CFP · 2352 x 1568 pixels:
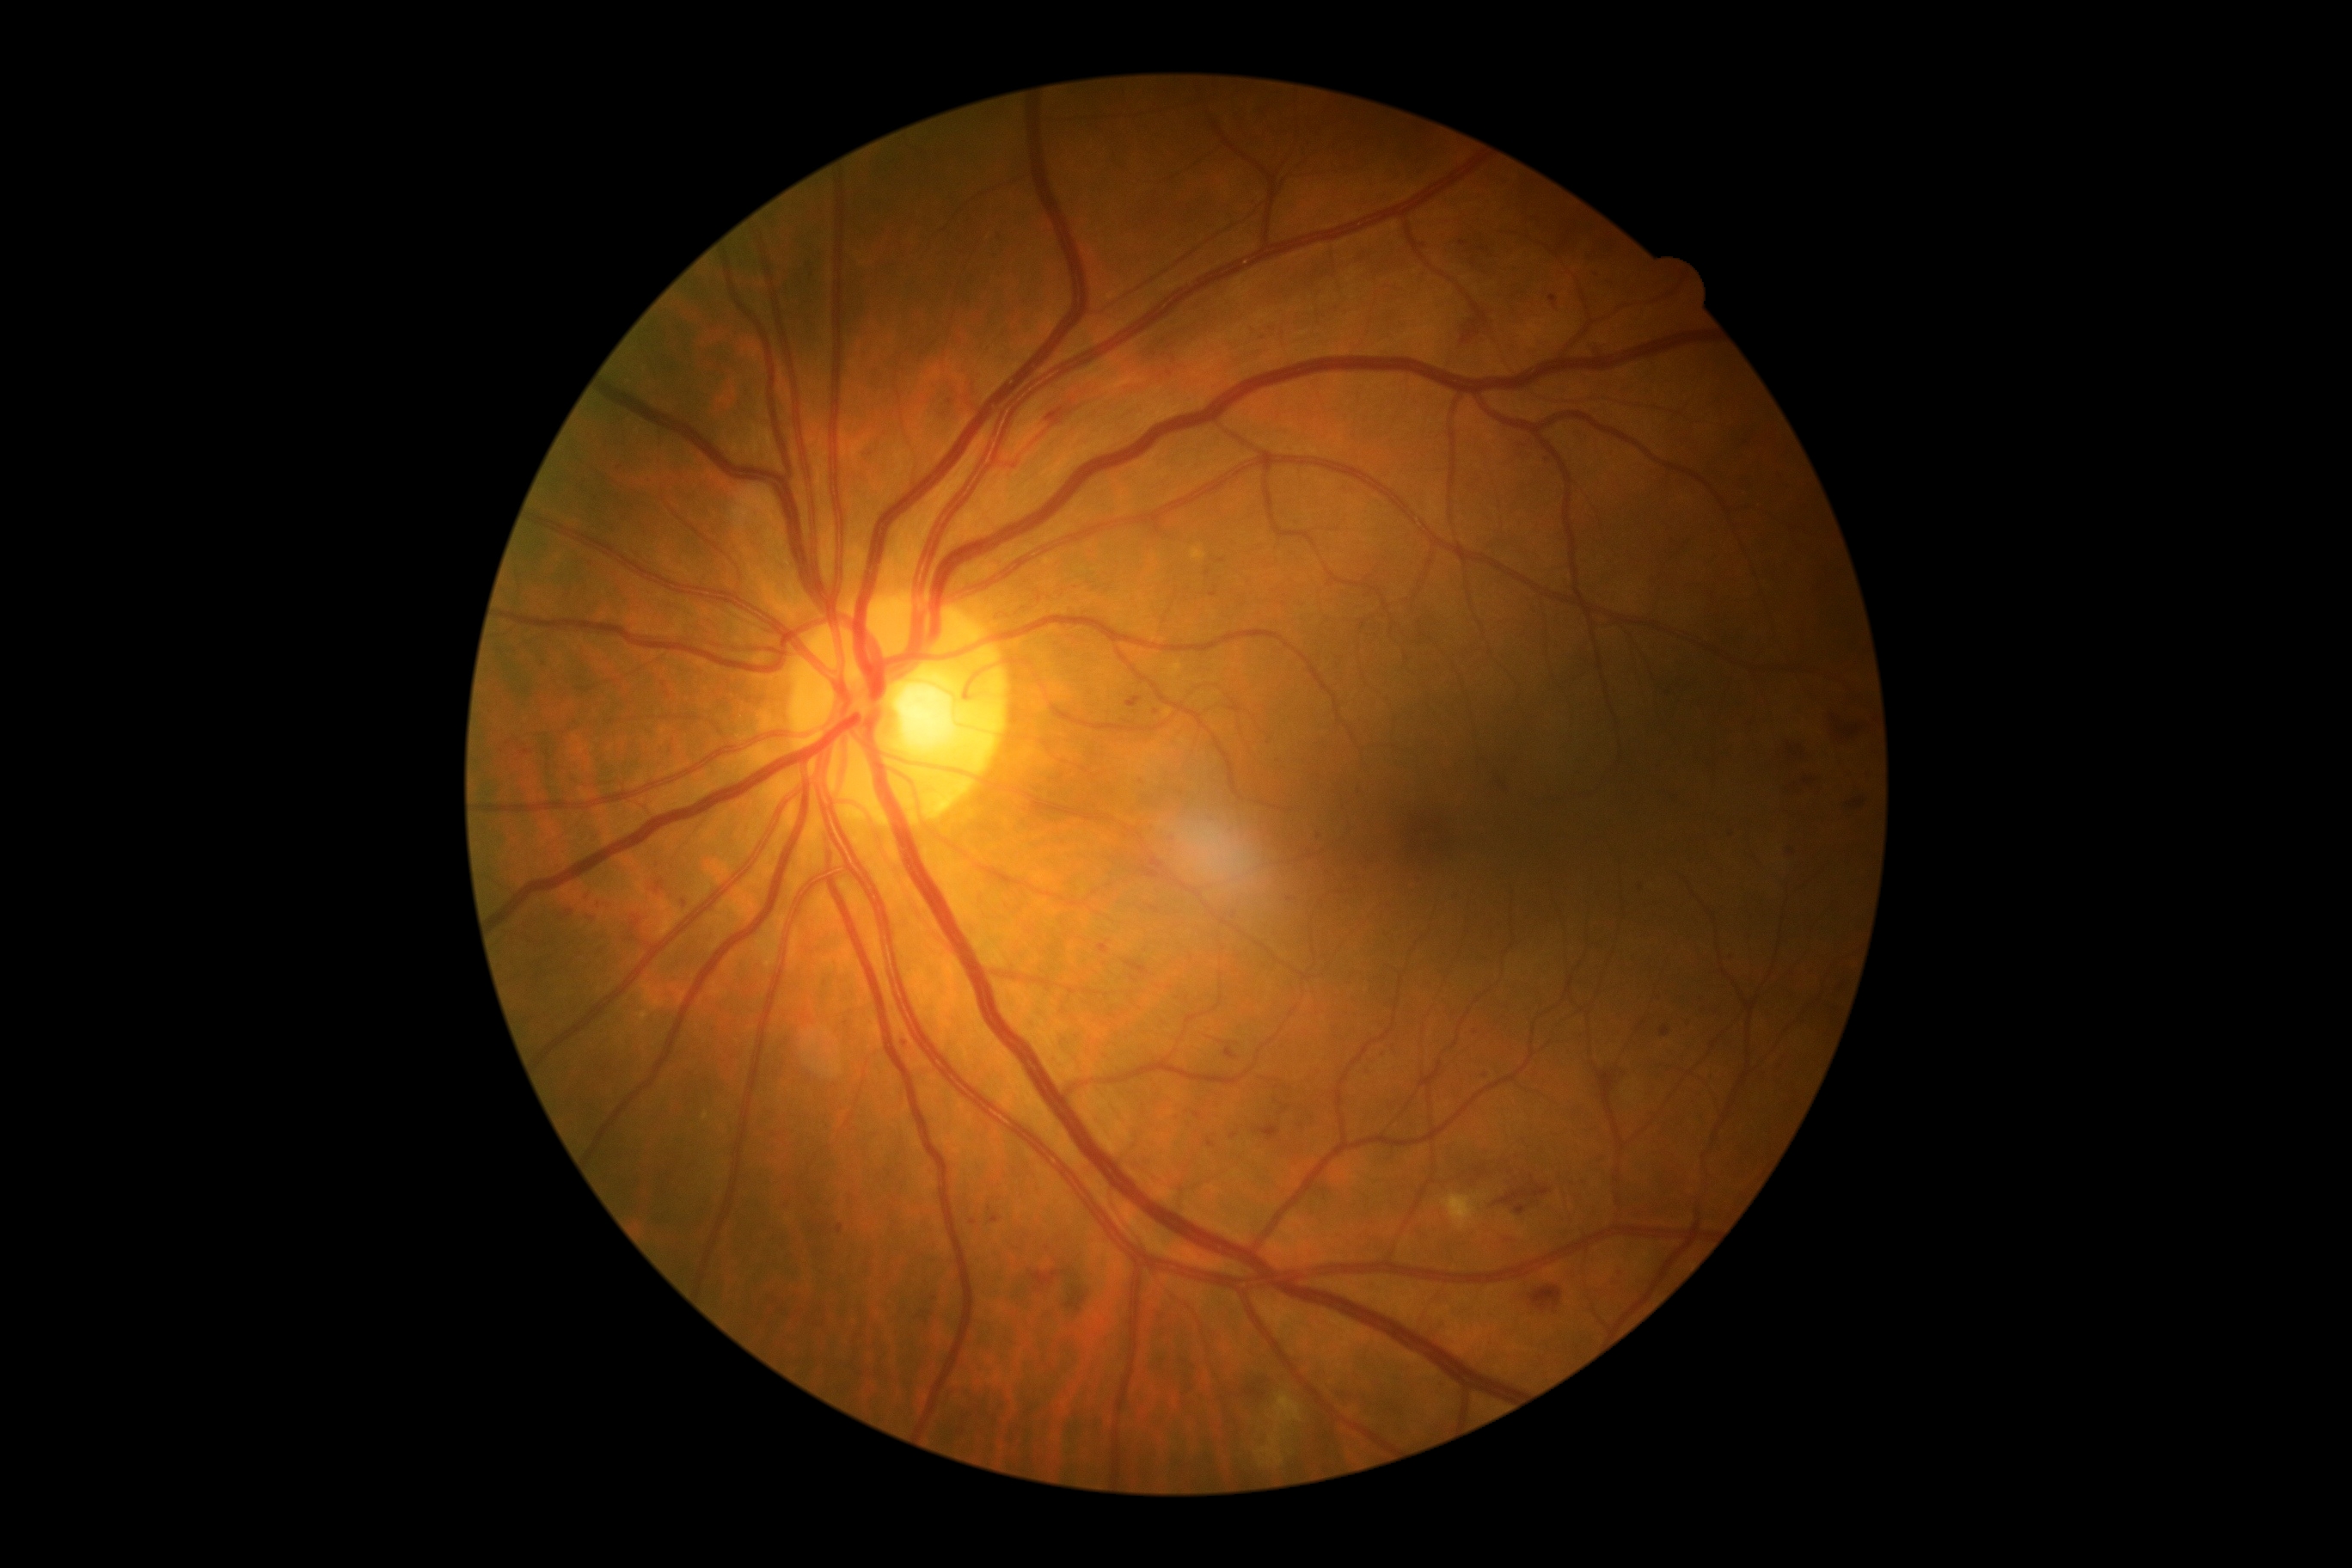 DR class: non-proliferative diabetic retinopathy
DR severity: grade 2